2352x1568px
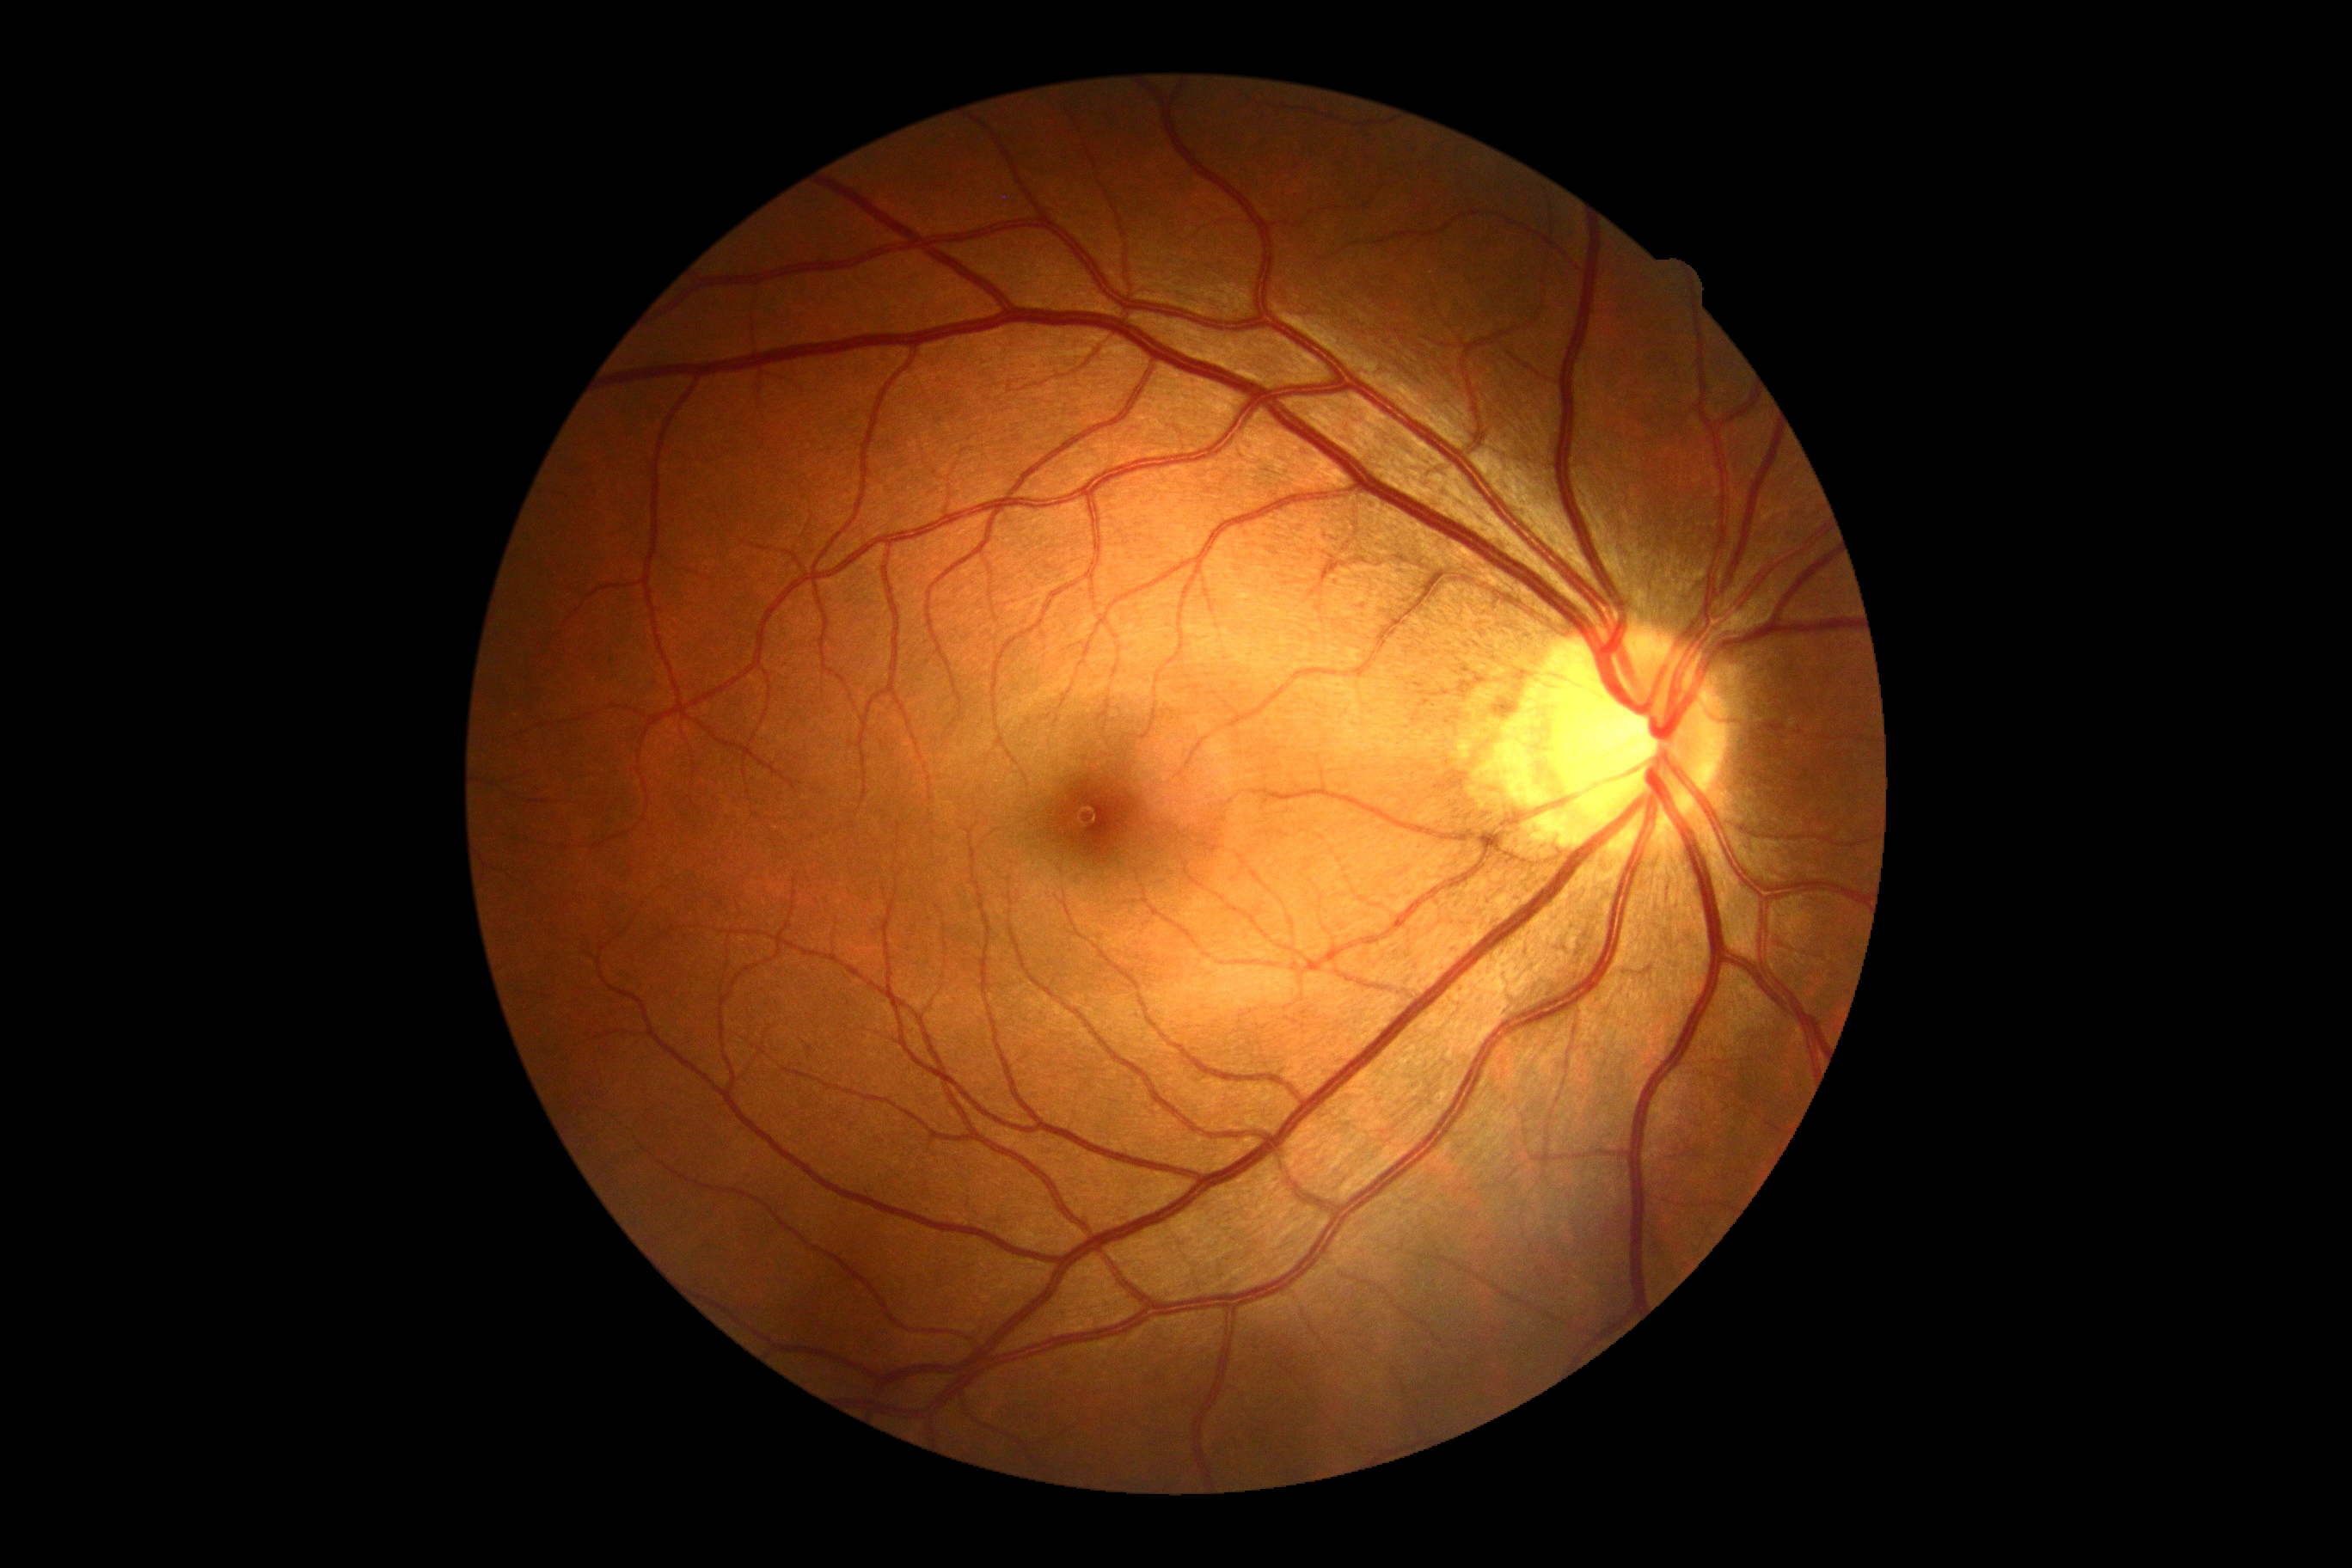
{
  "dr_grade": "0/4"
}